Davis DR grading: 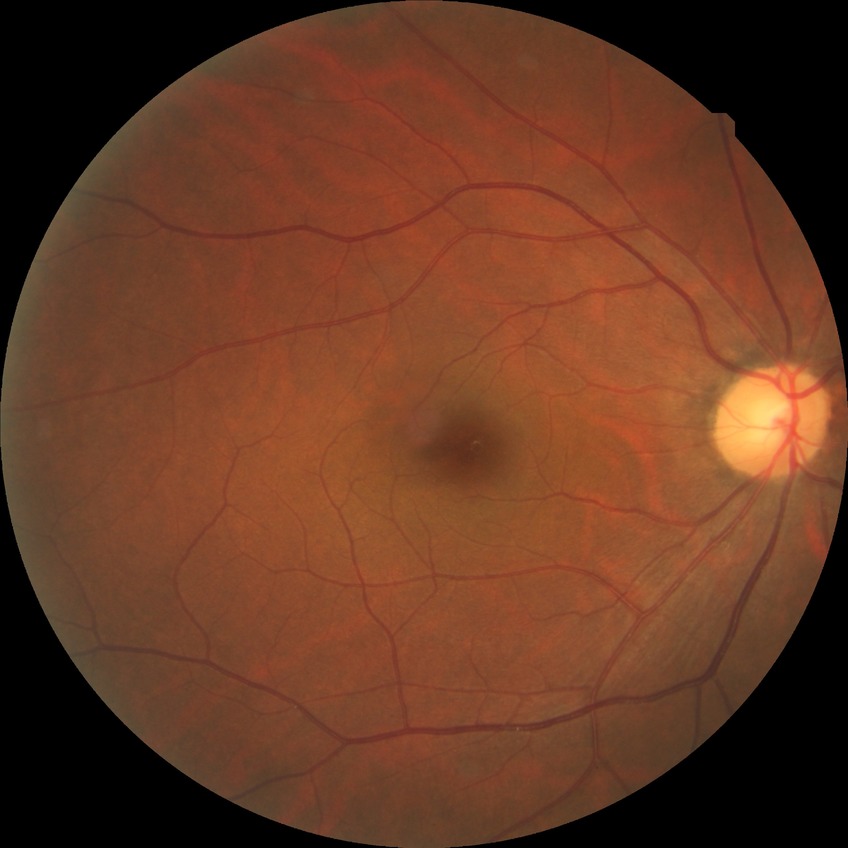
Findings:
- diabetic retinopathy (DR): no diabetic retinopathy (NDR)